45° field of view; color fundus photograph: 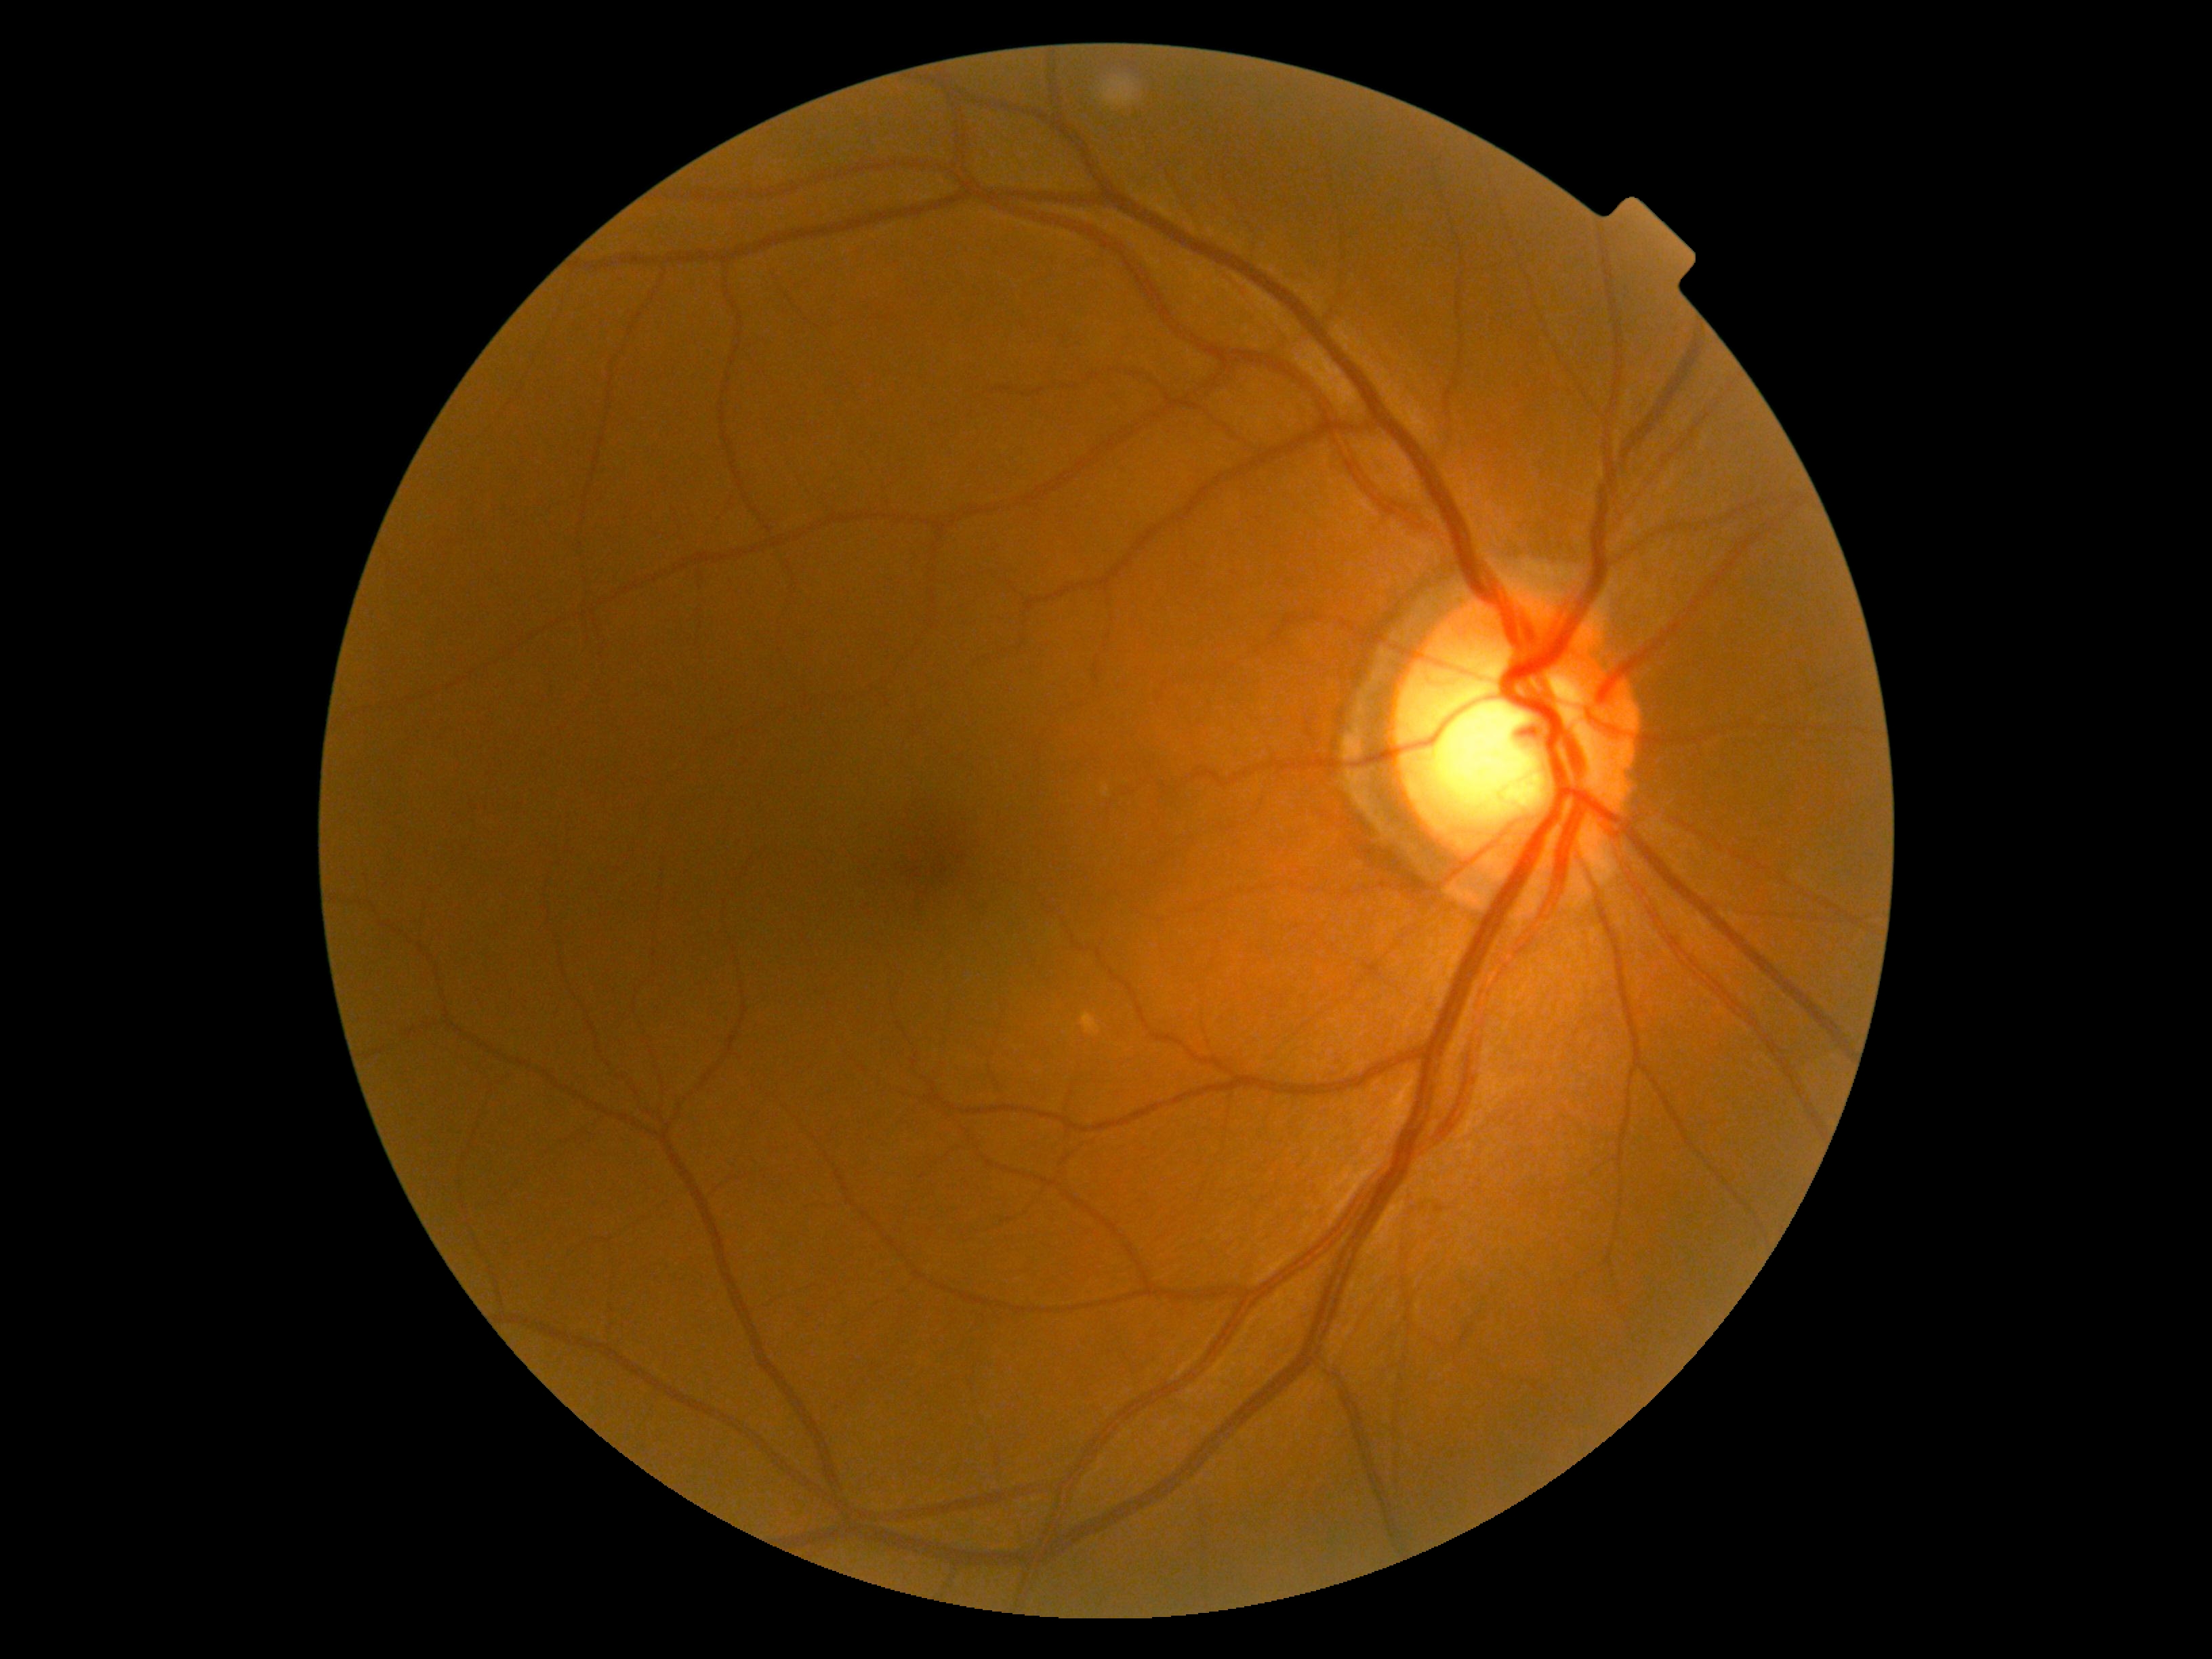

DR stage=grade 0 (no apparent retinopathy).